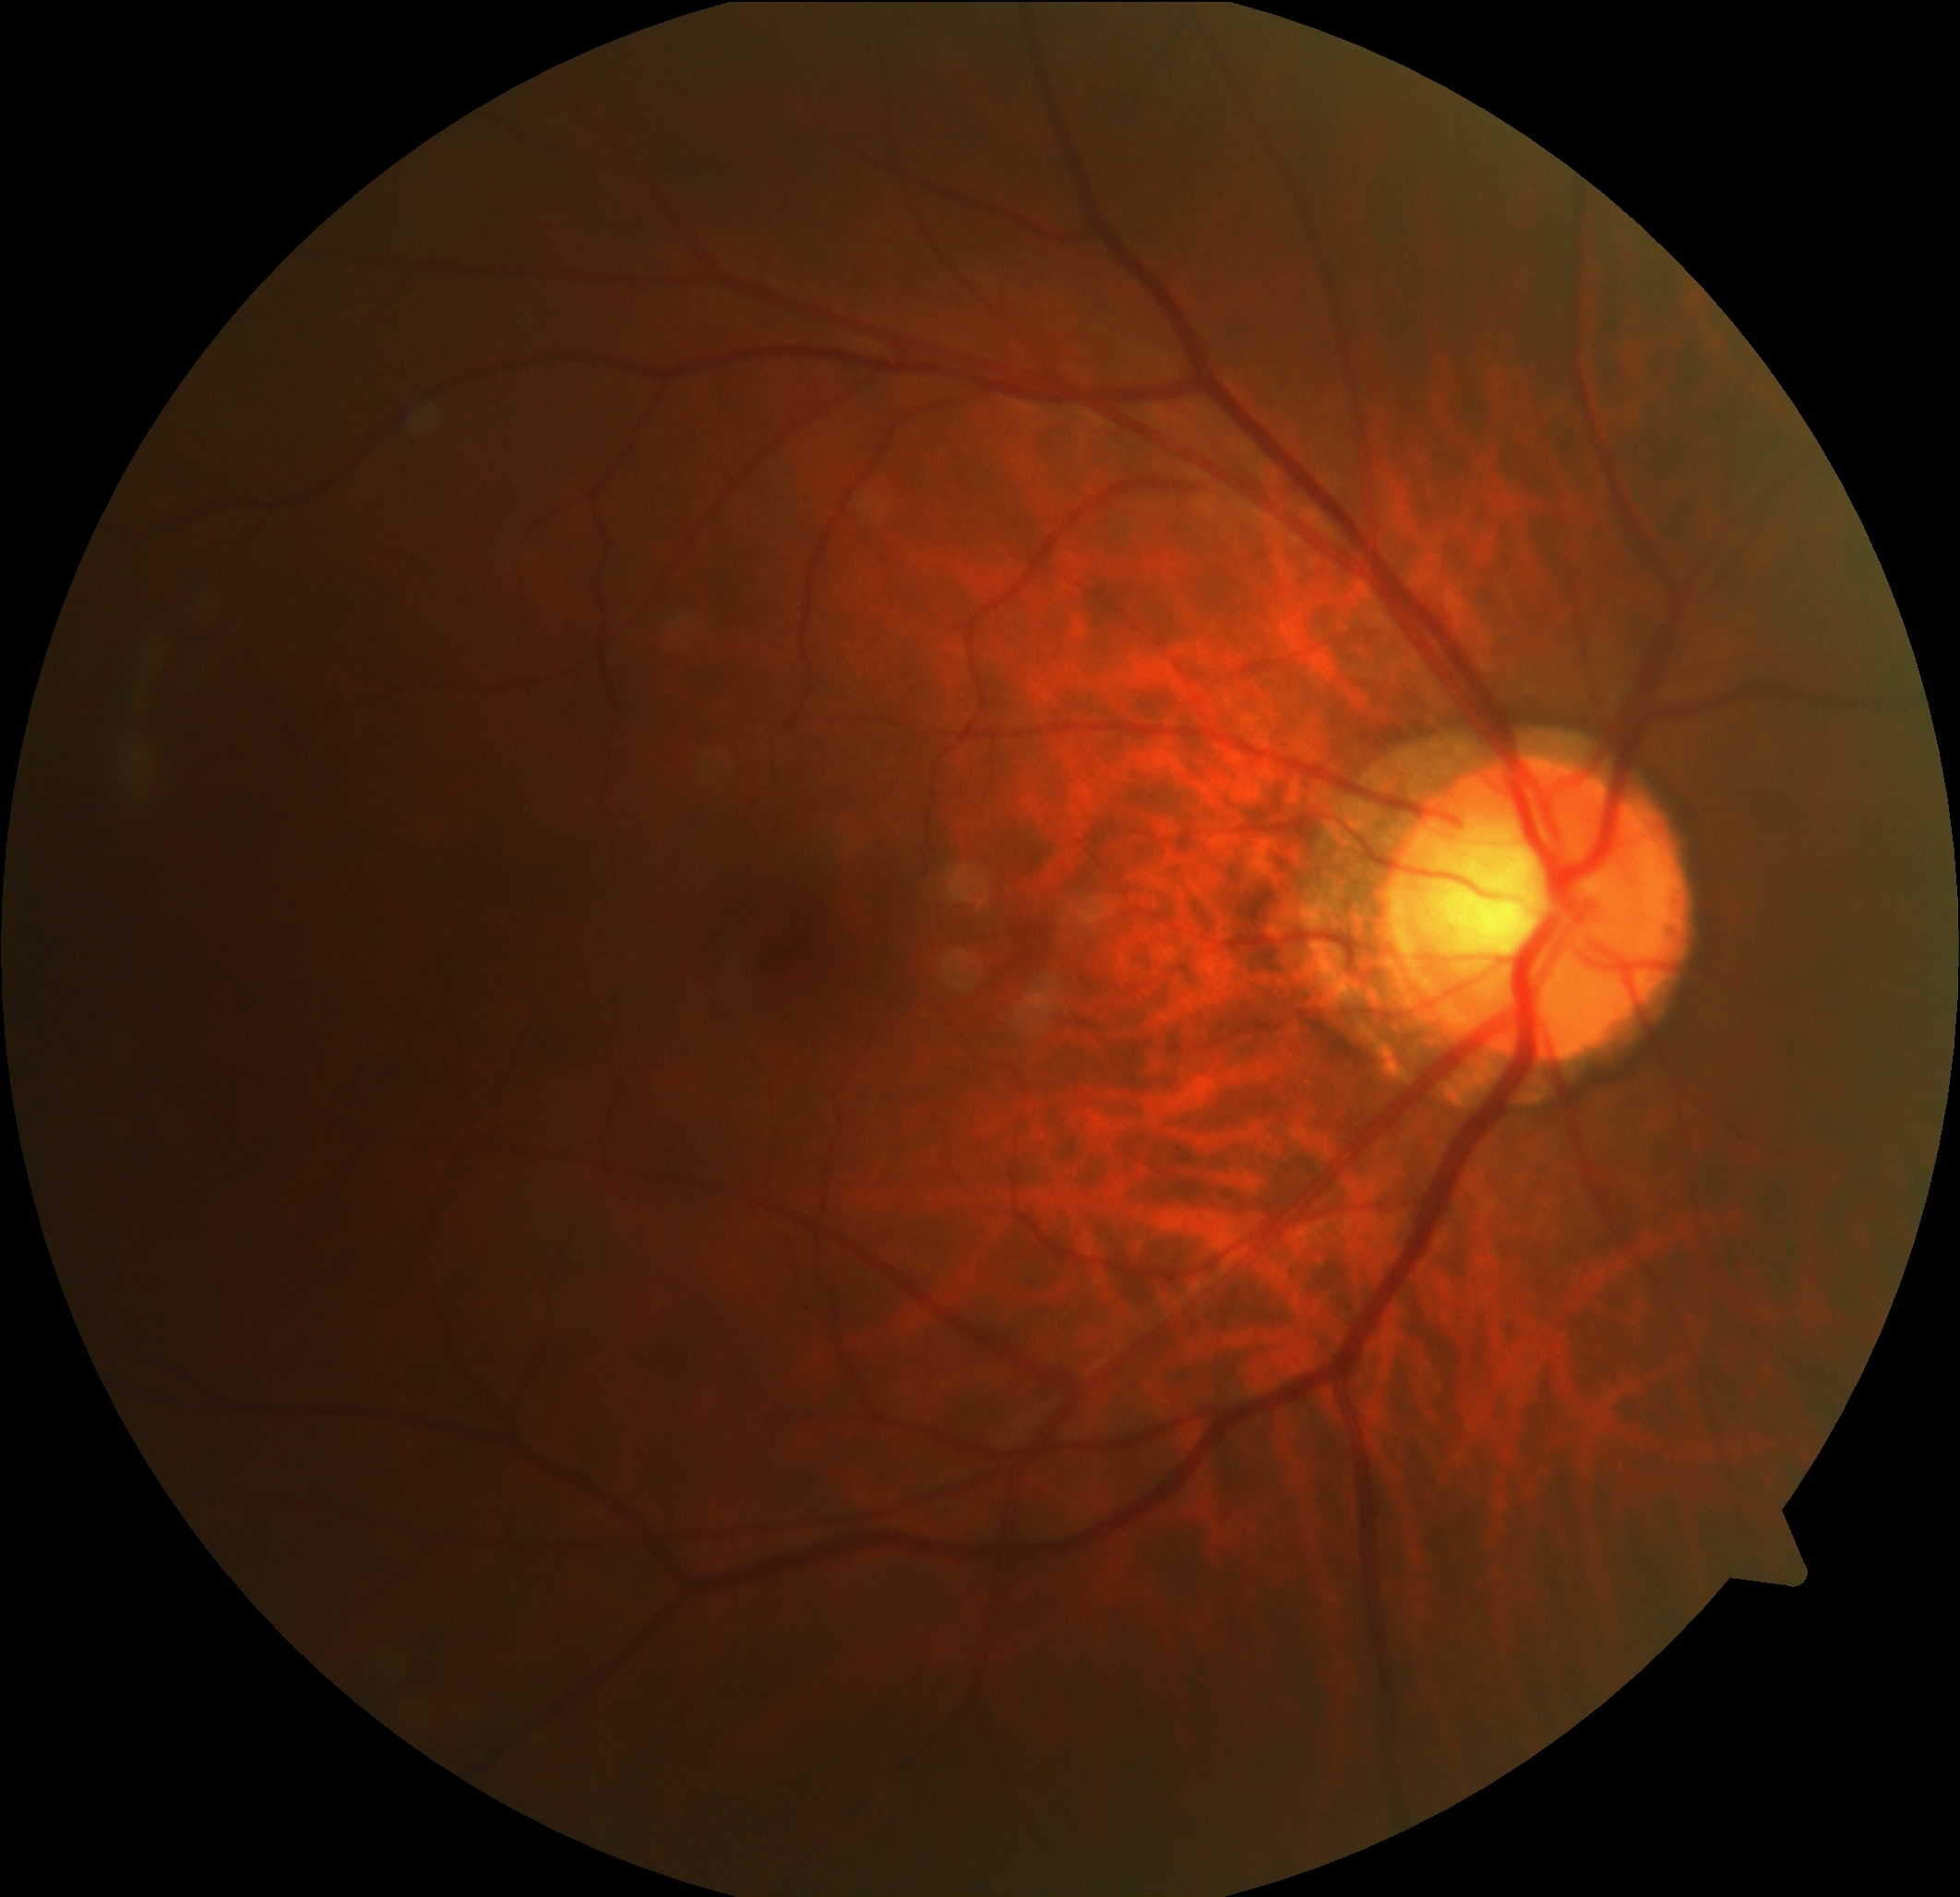

No diabetic retinal disease findings. Diabetic retinopathy severity is no apparent retinopathy (grade 0).